Color fundus photograph, 2089x1764.
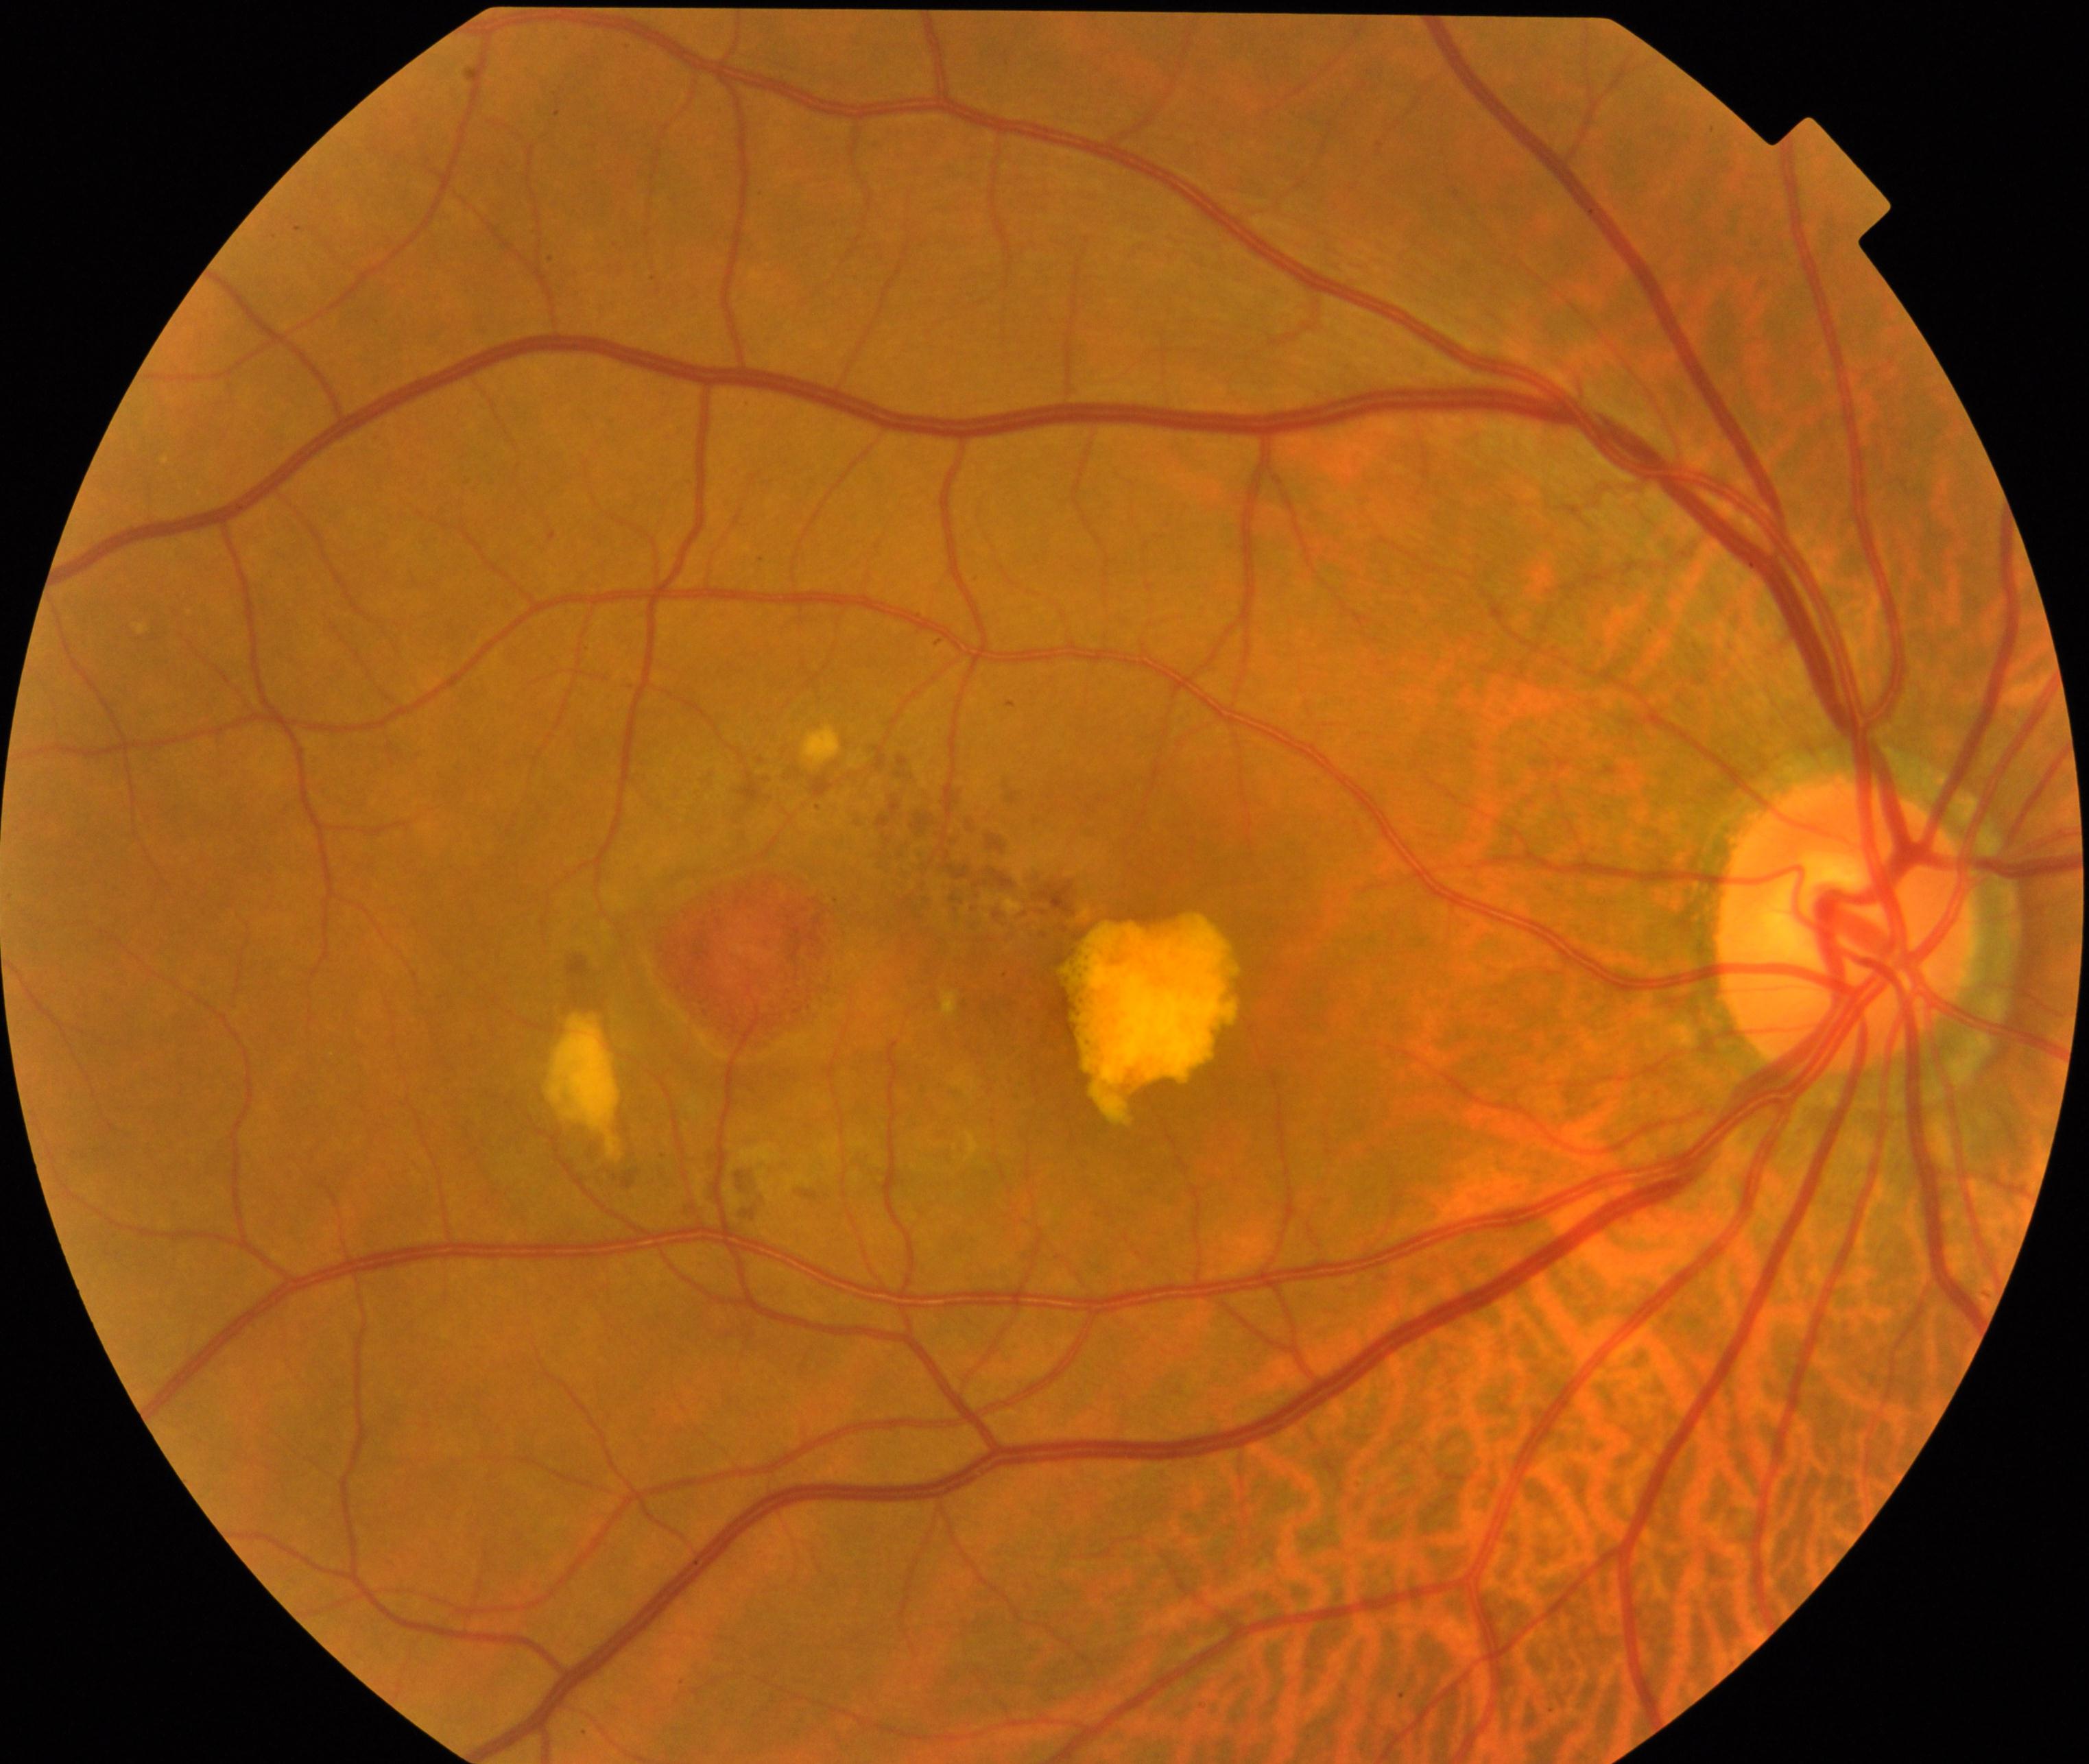

The image shows maculopathy.